Camera: Kowa VX-10α.
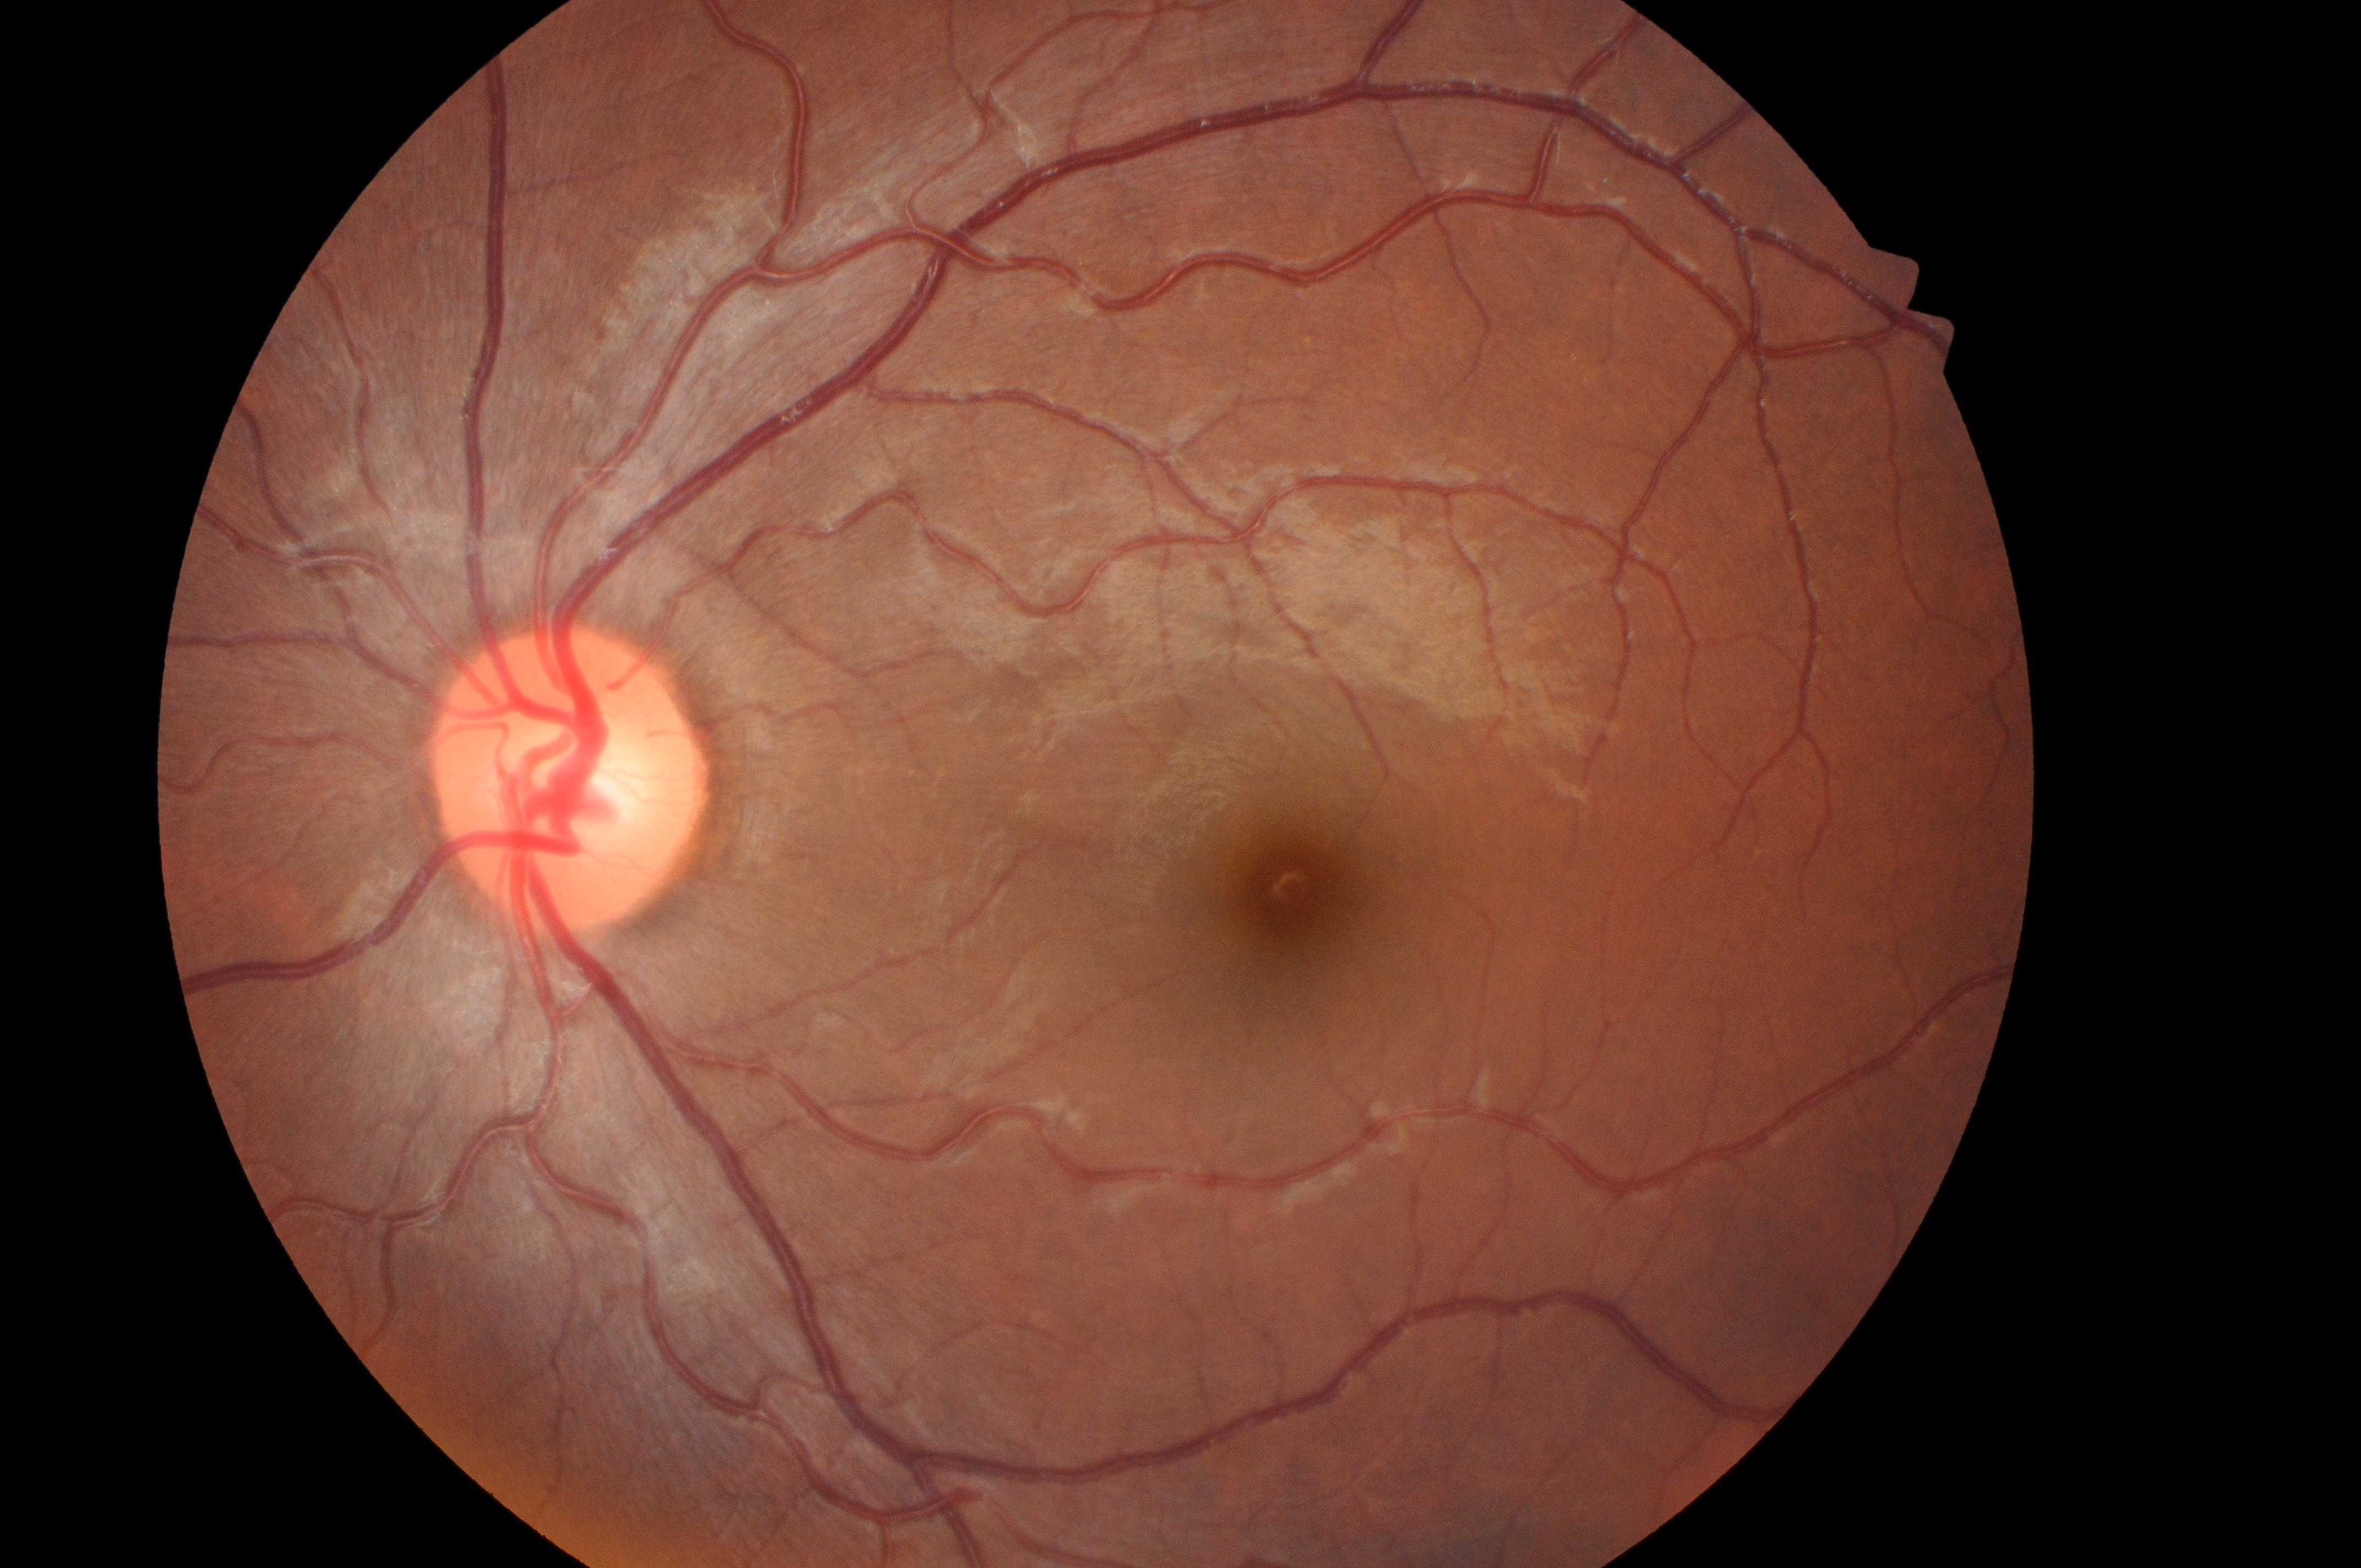

| key | value |
|---|---|
| diabetic macular edema (DME) | no risk (grade 0) |
| diabetic retinopathy (DR) | grade 0 (no apparent retinopathy) |
| optic nerve head | 559px, 792px |
| eye | OS |
| fovea centralis | 1289px, 892px |